1932 by 1932 pixels; acquired with a Topcon TRC-NW8.
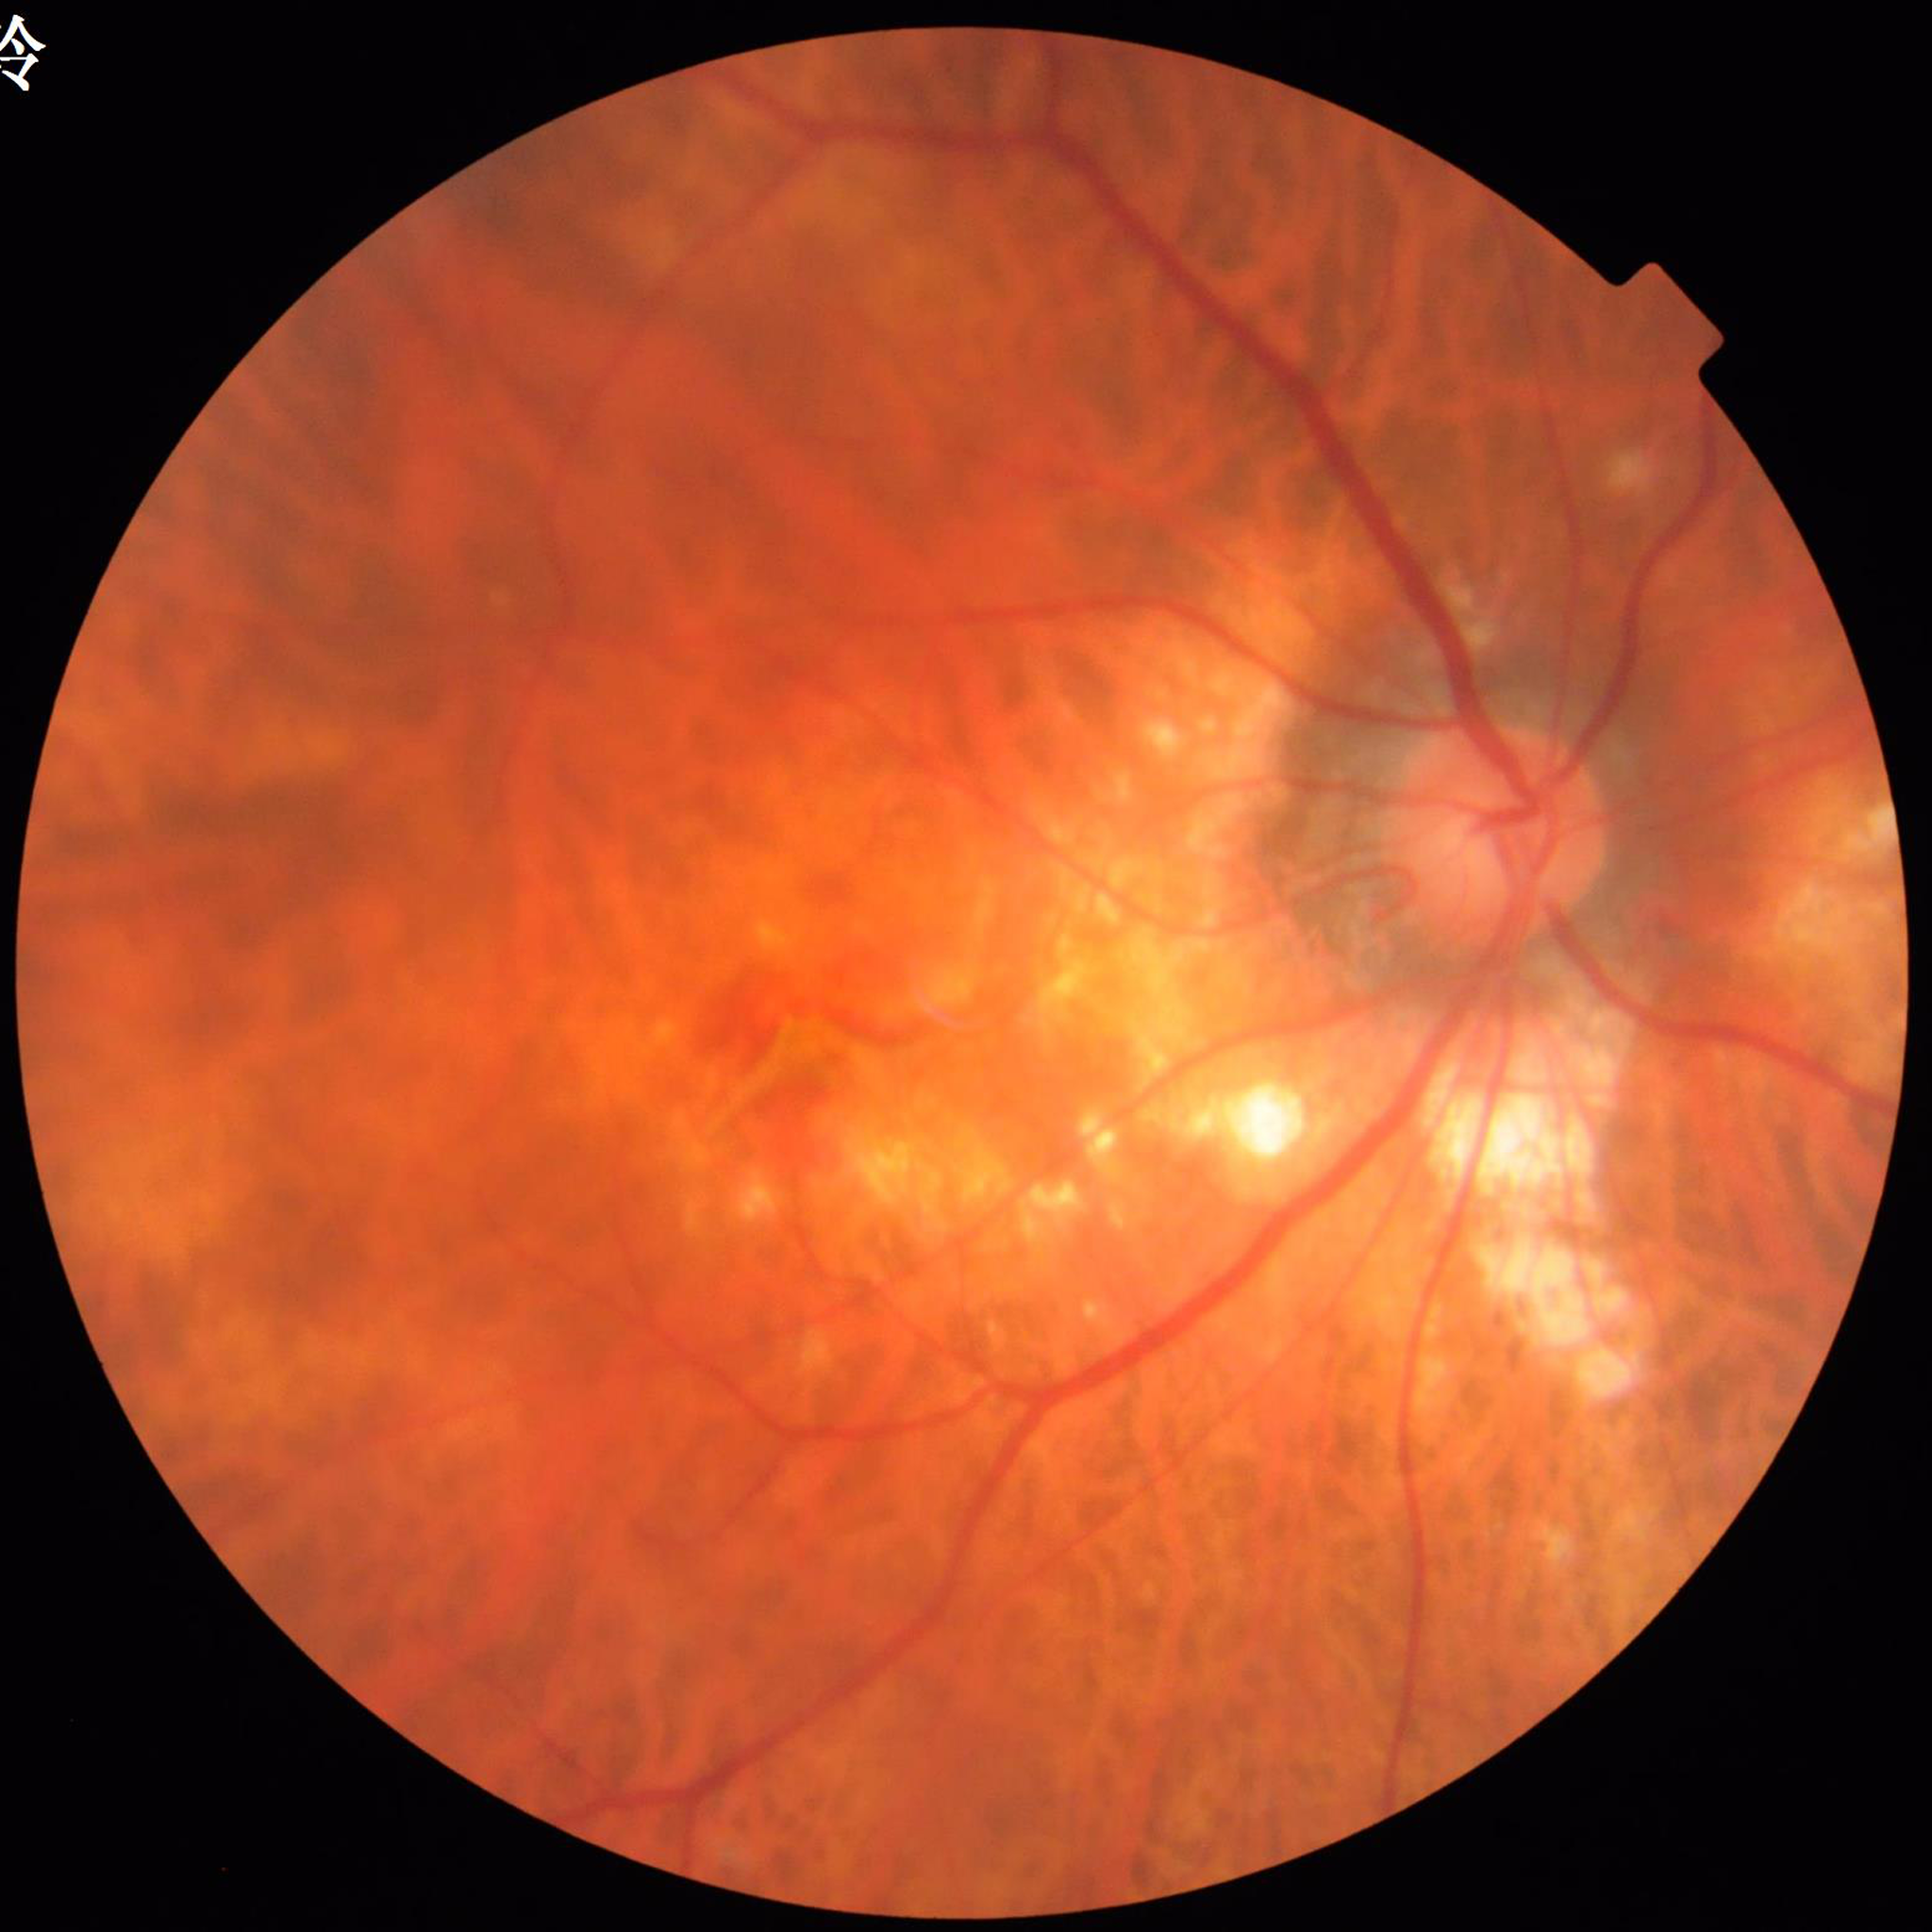 Quality: good. Patient diagnosed with age-related macular degeneration (AMD).